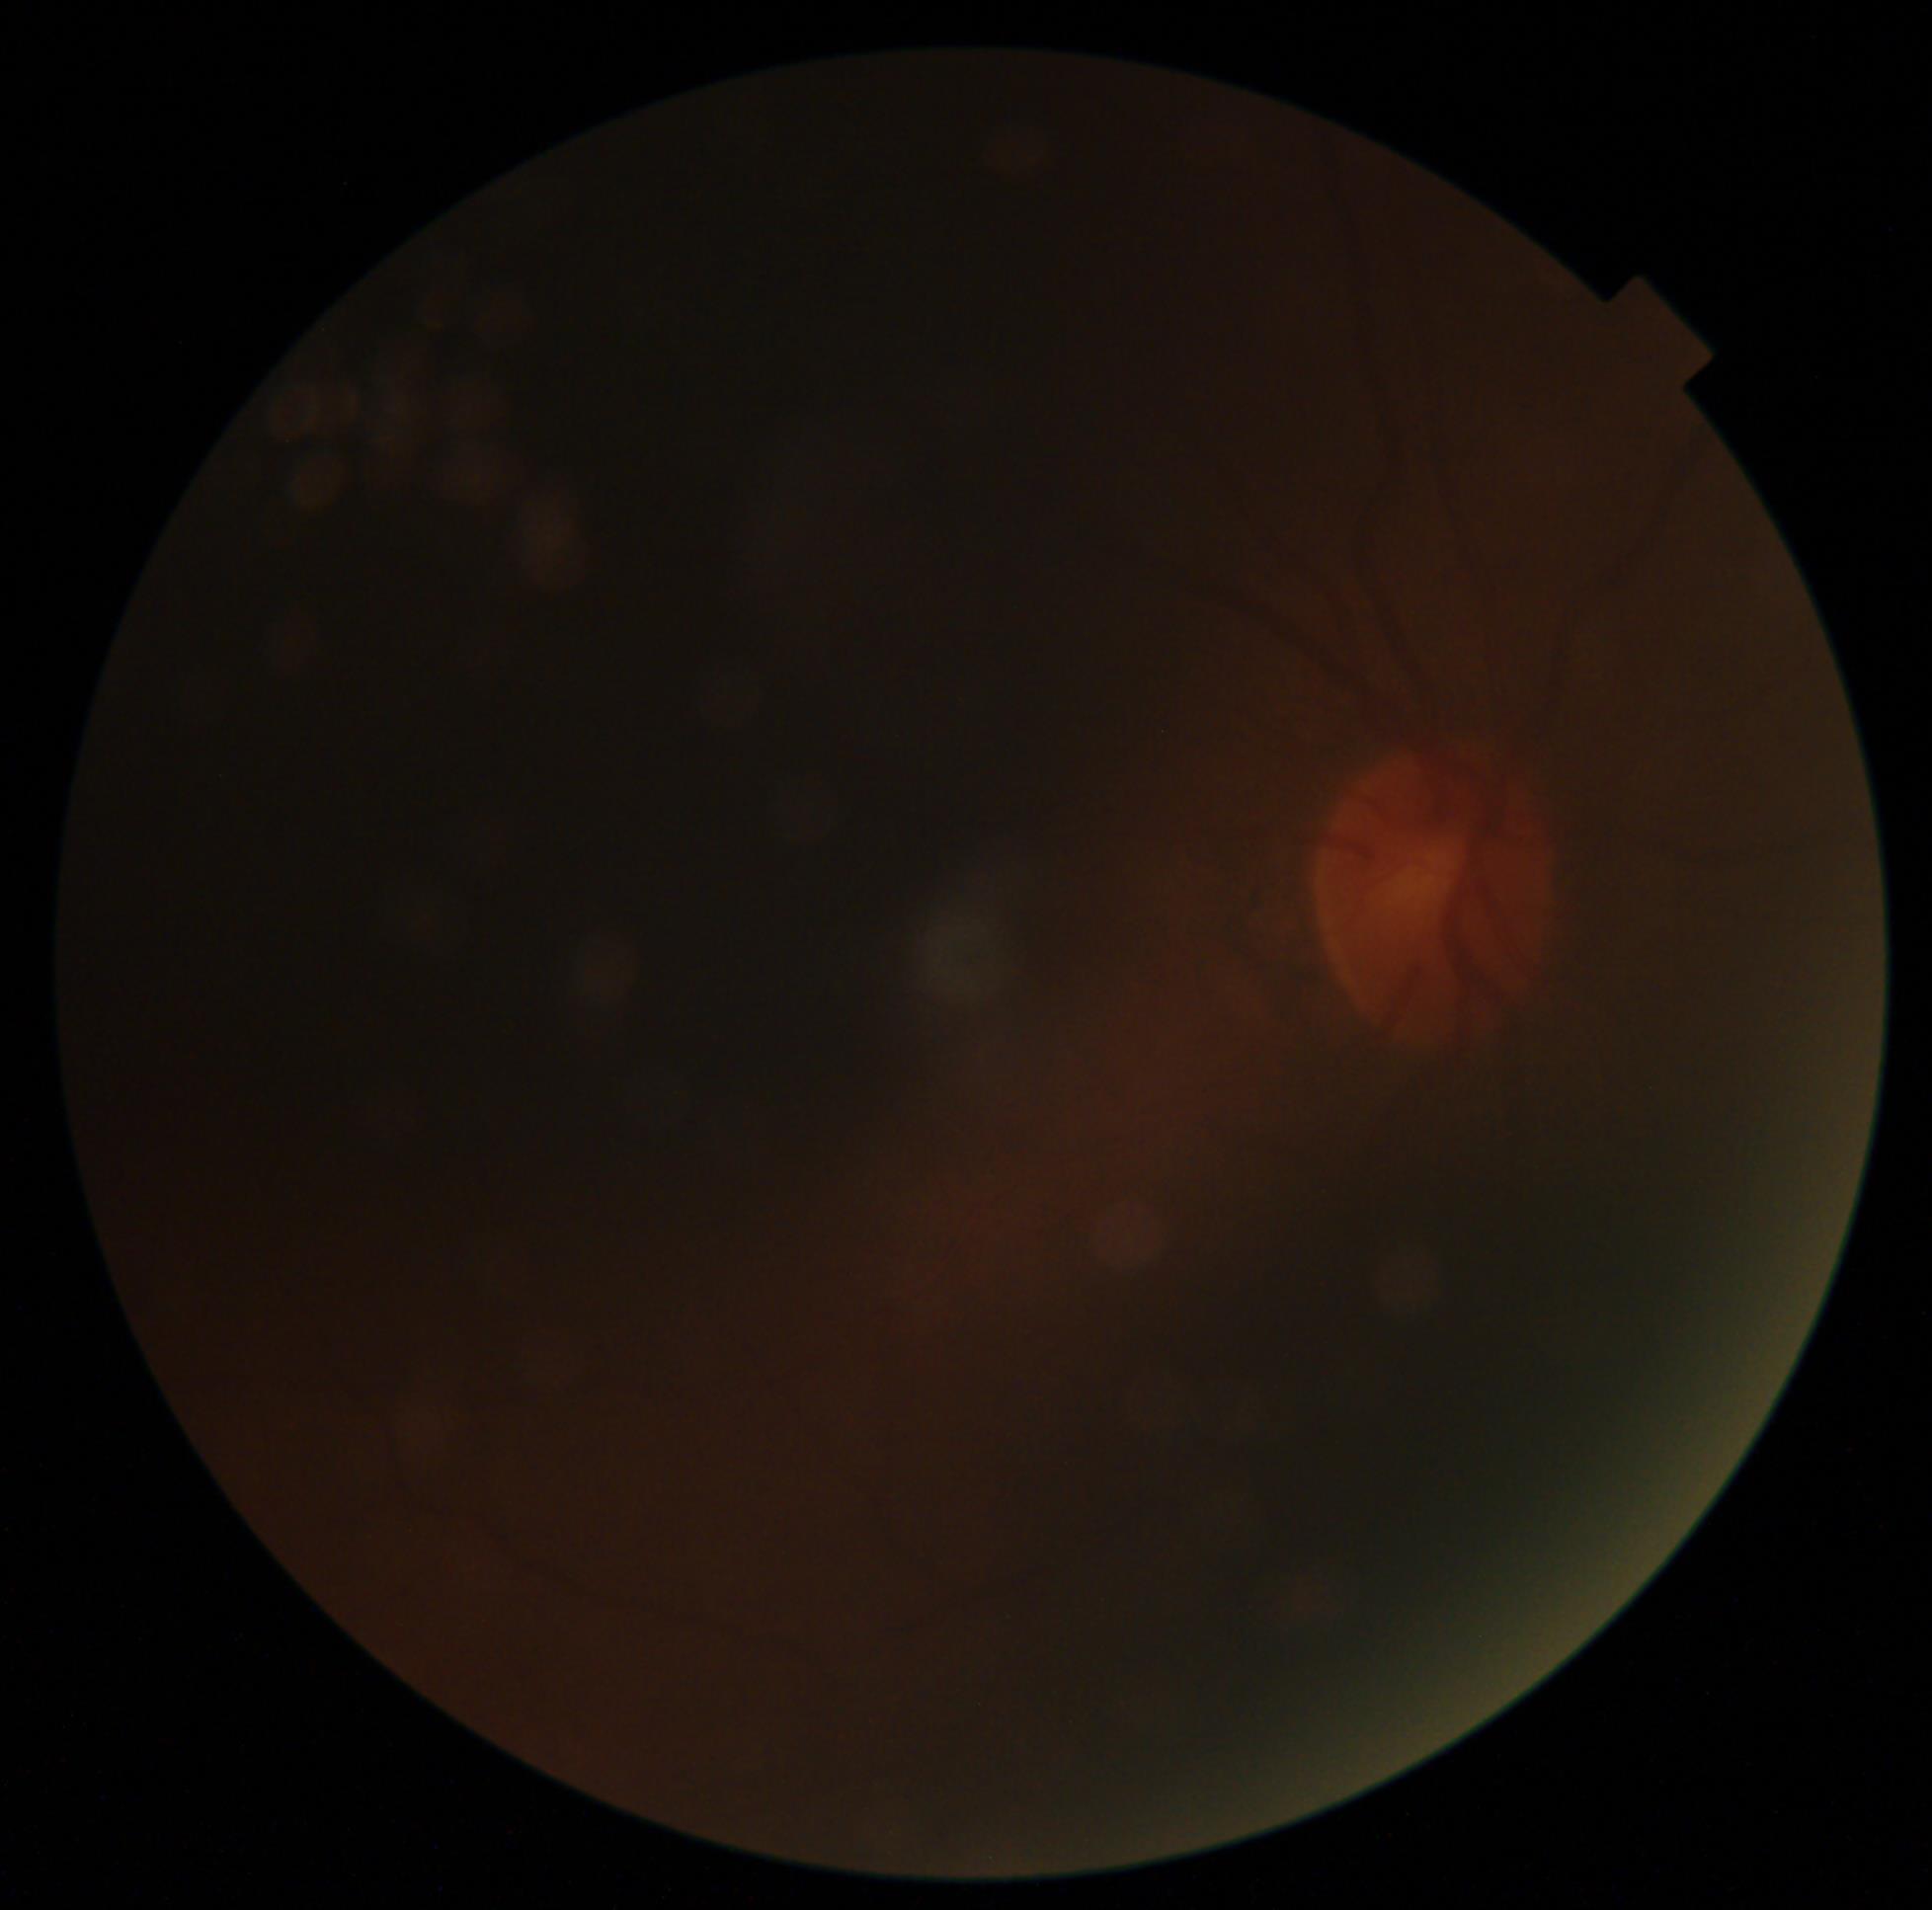 {
  "dr_grade": "ungradable",
  "quality": "too poor for DR grading"
}